130° field of view (Clarity RetCam 3); 640x480; wide-field fundus photograph from neonatal ROP screening
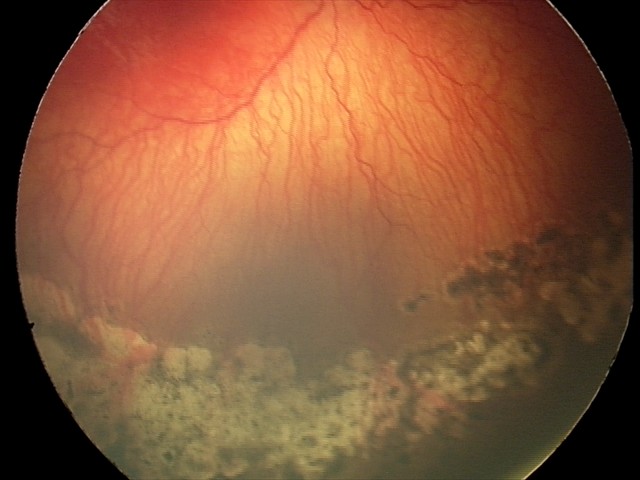 Plus disease present.
Series diagnosed as aggressive retinopathy of prematurity.